Wide-field contact fundus photograph of an infant:
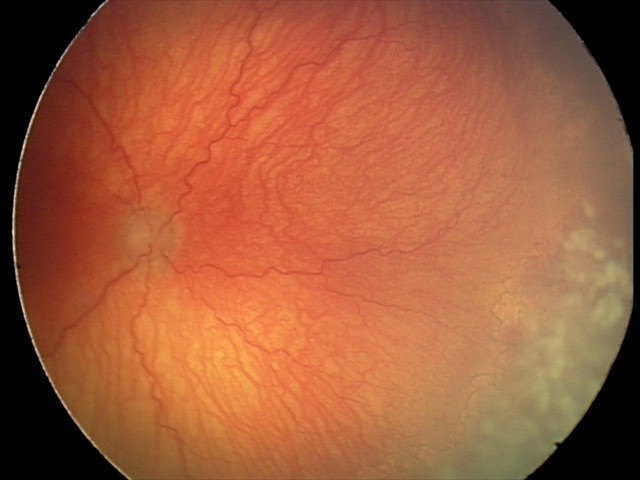
Plus disease present. From an examination with diagnosis of A-ROP (aggressive ROP).